848 by 848 pixels, modified Davis grading
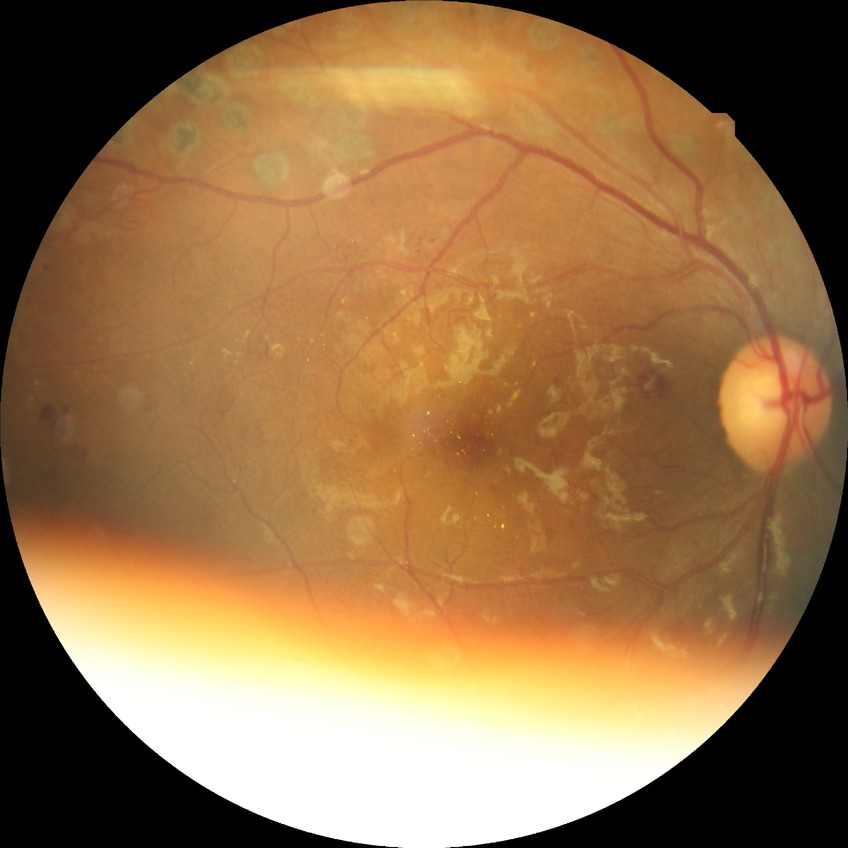

Diabetic retinopathy (DR) is proliferative diabetic retinopathy (PDR).